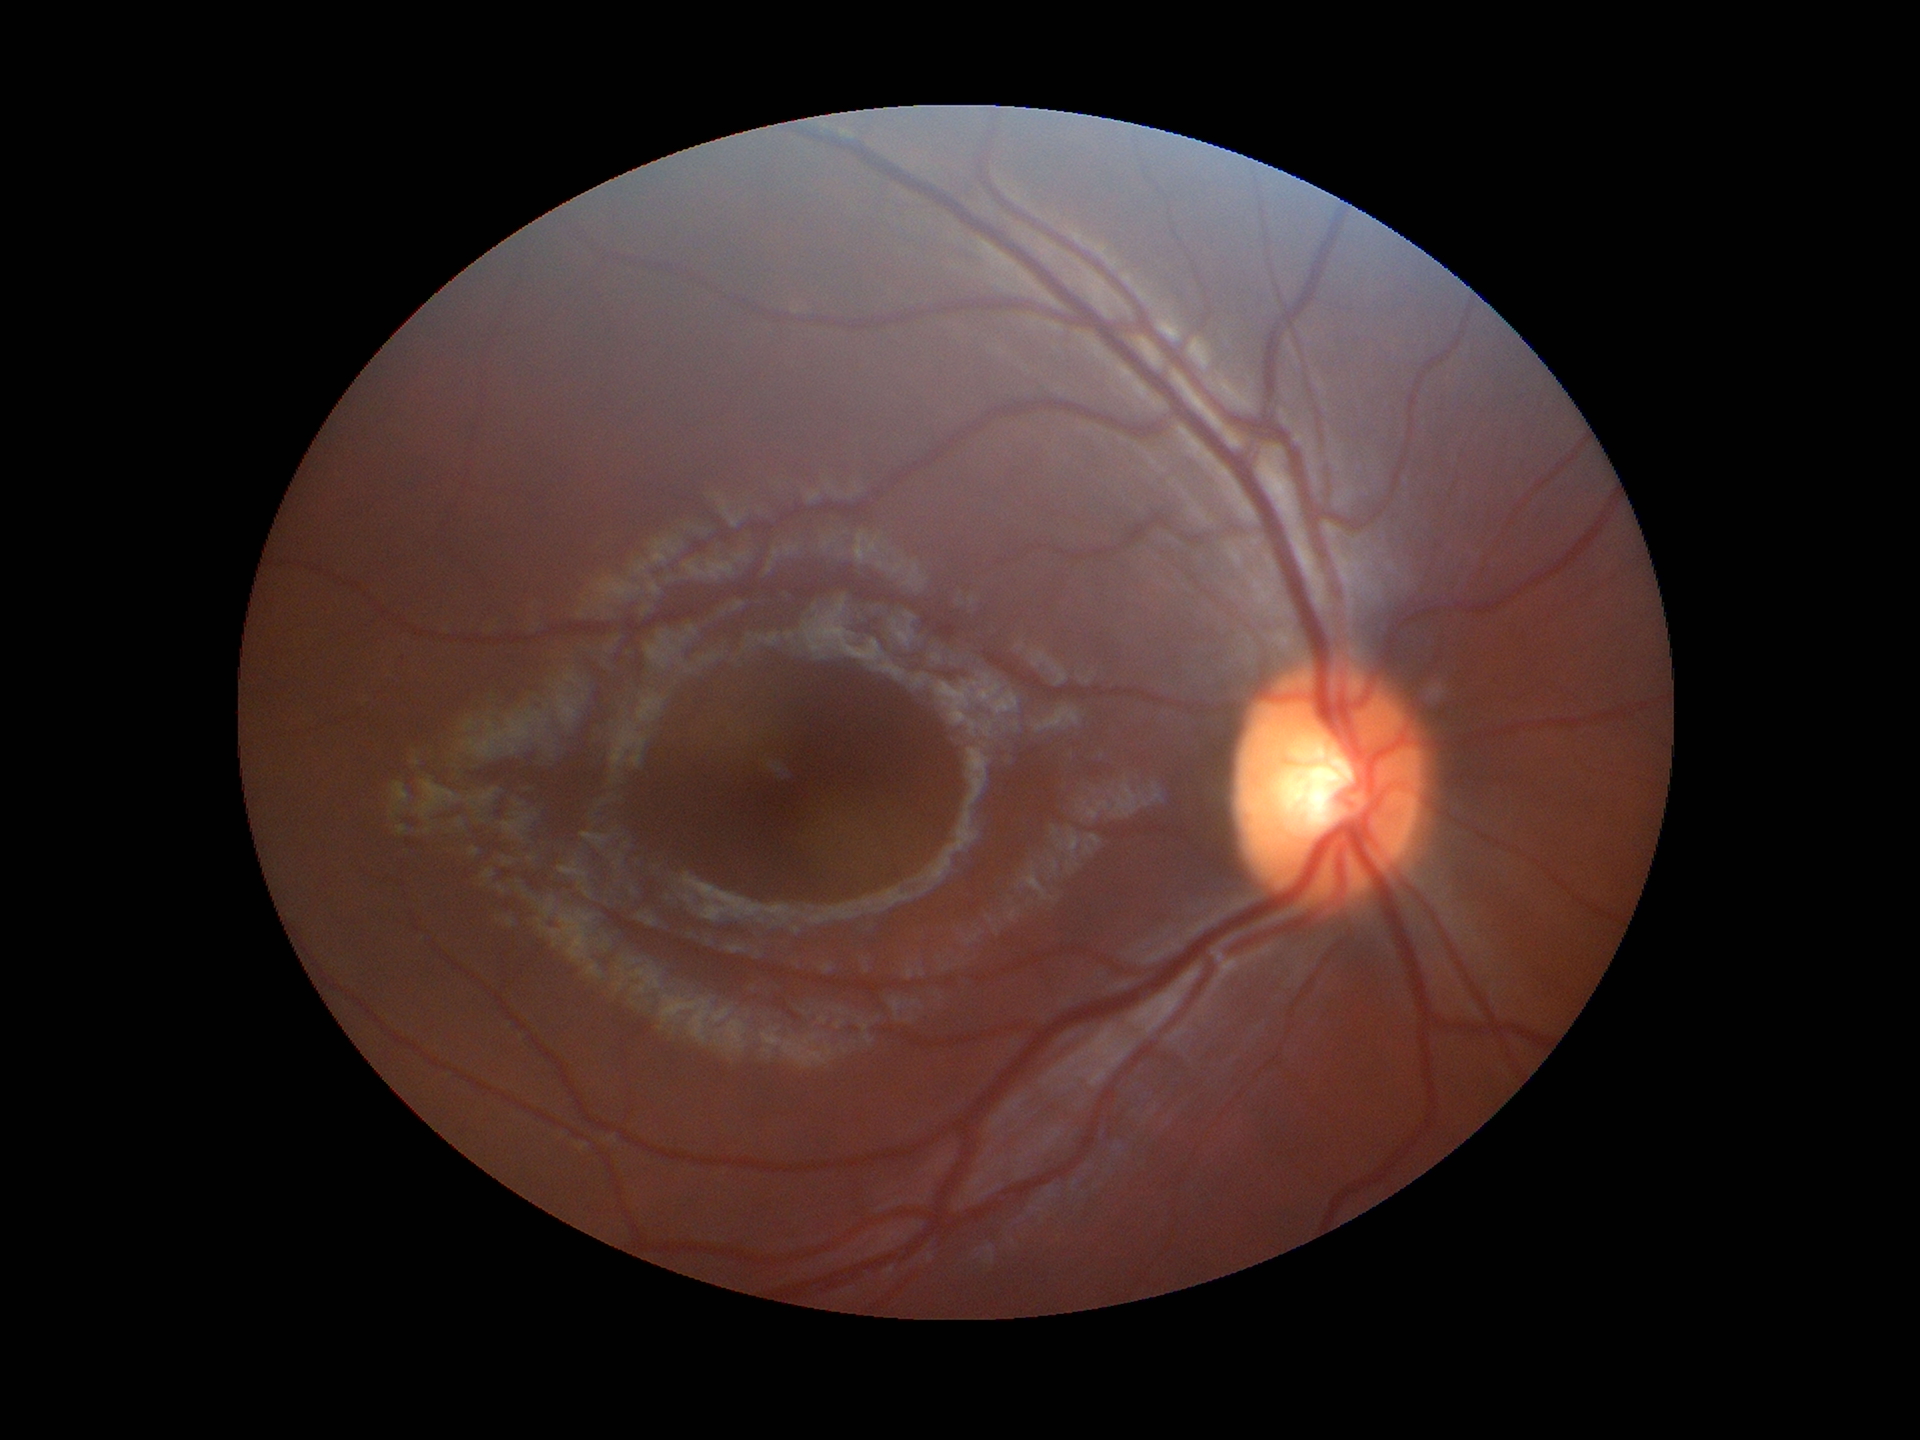

glaucoma_decision: not suspect (all 5 graders called normal)
vcdr: 0.53